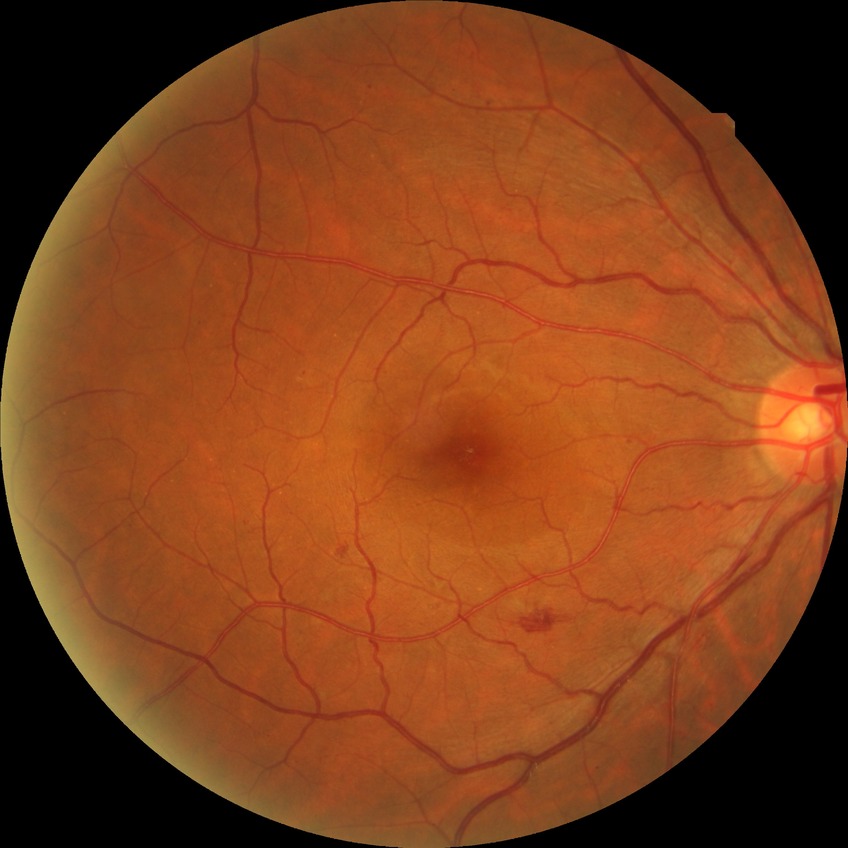 The retinopathy is classified as non-proliferative diabetic retinopathy. Modified Davis grade: SDR.